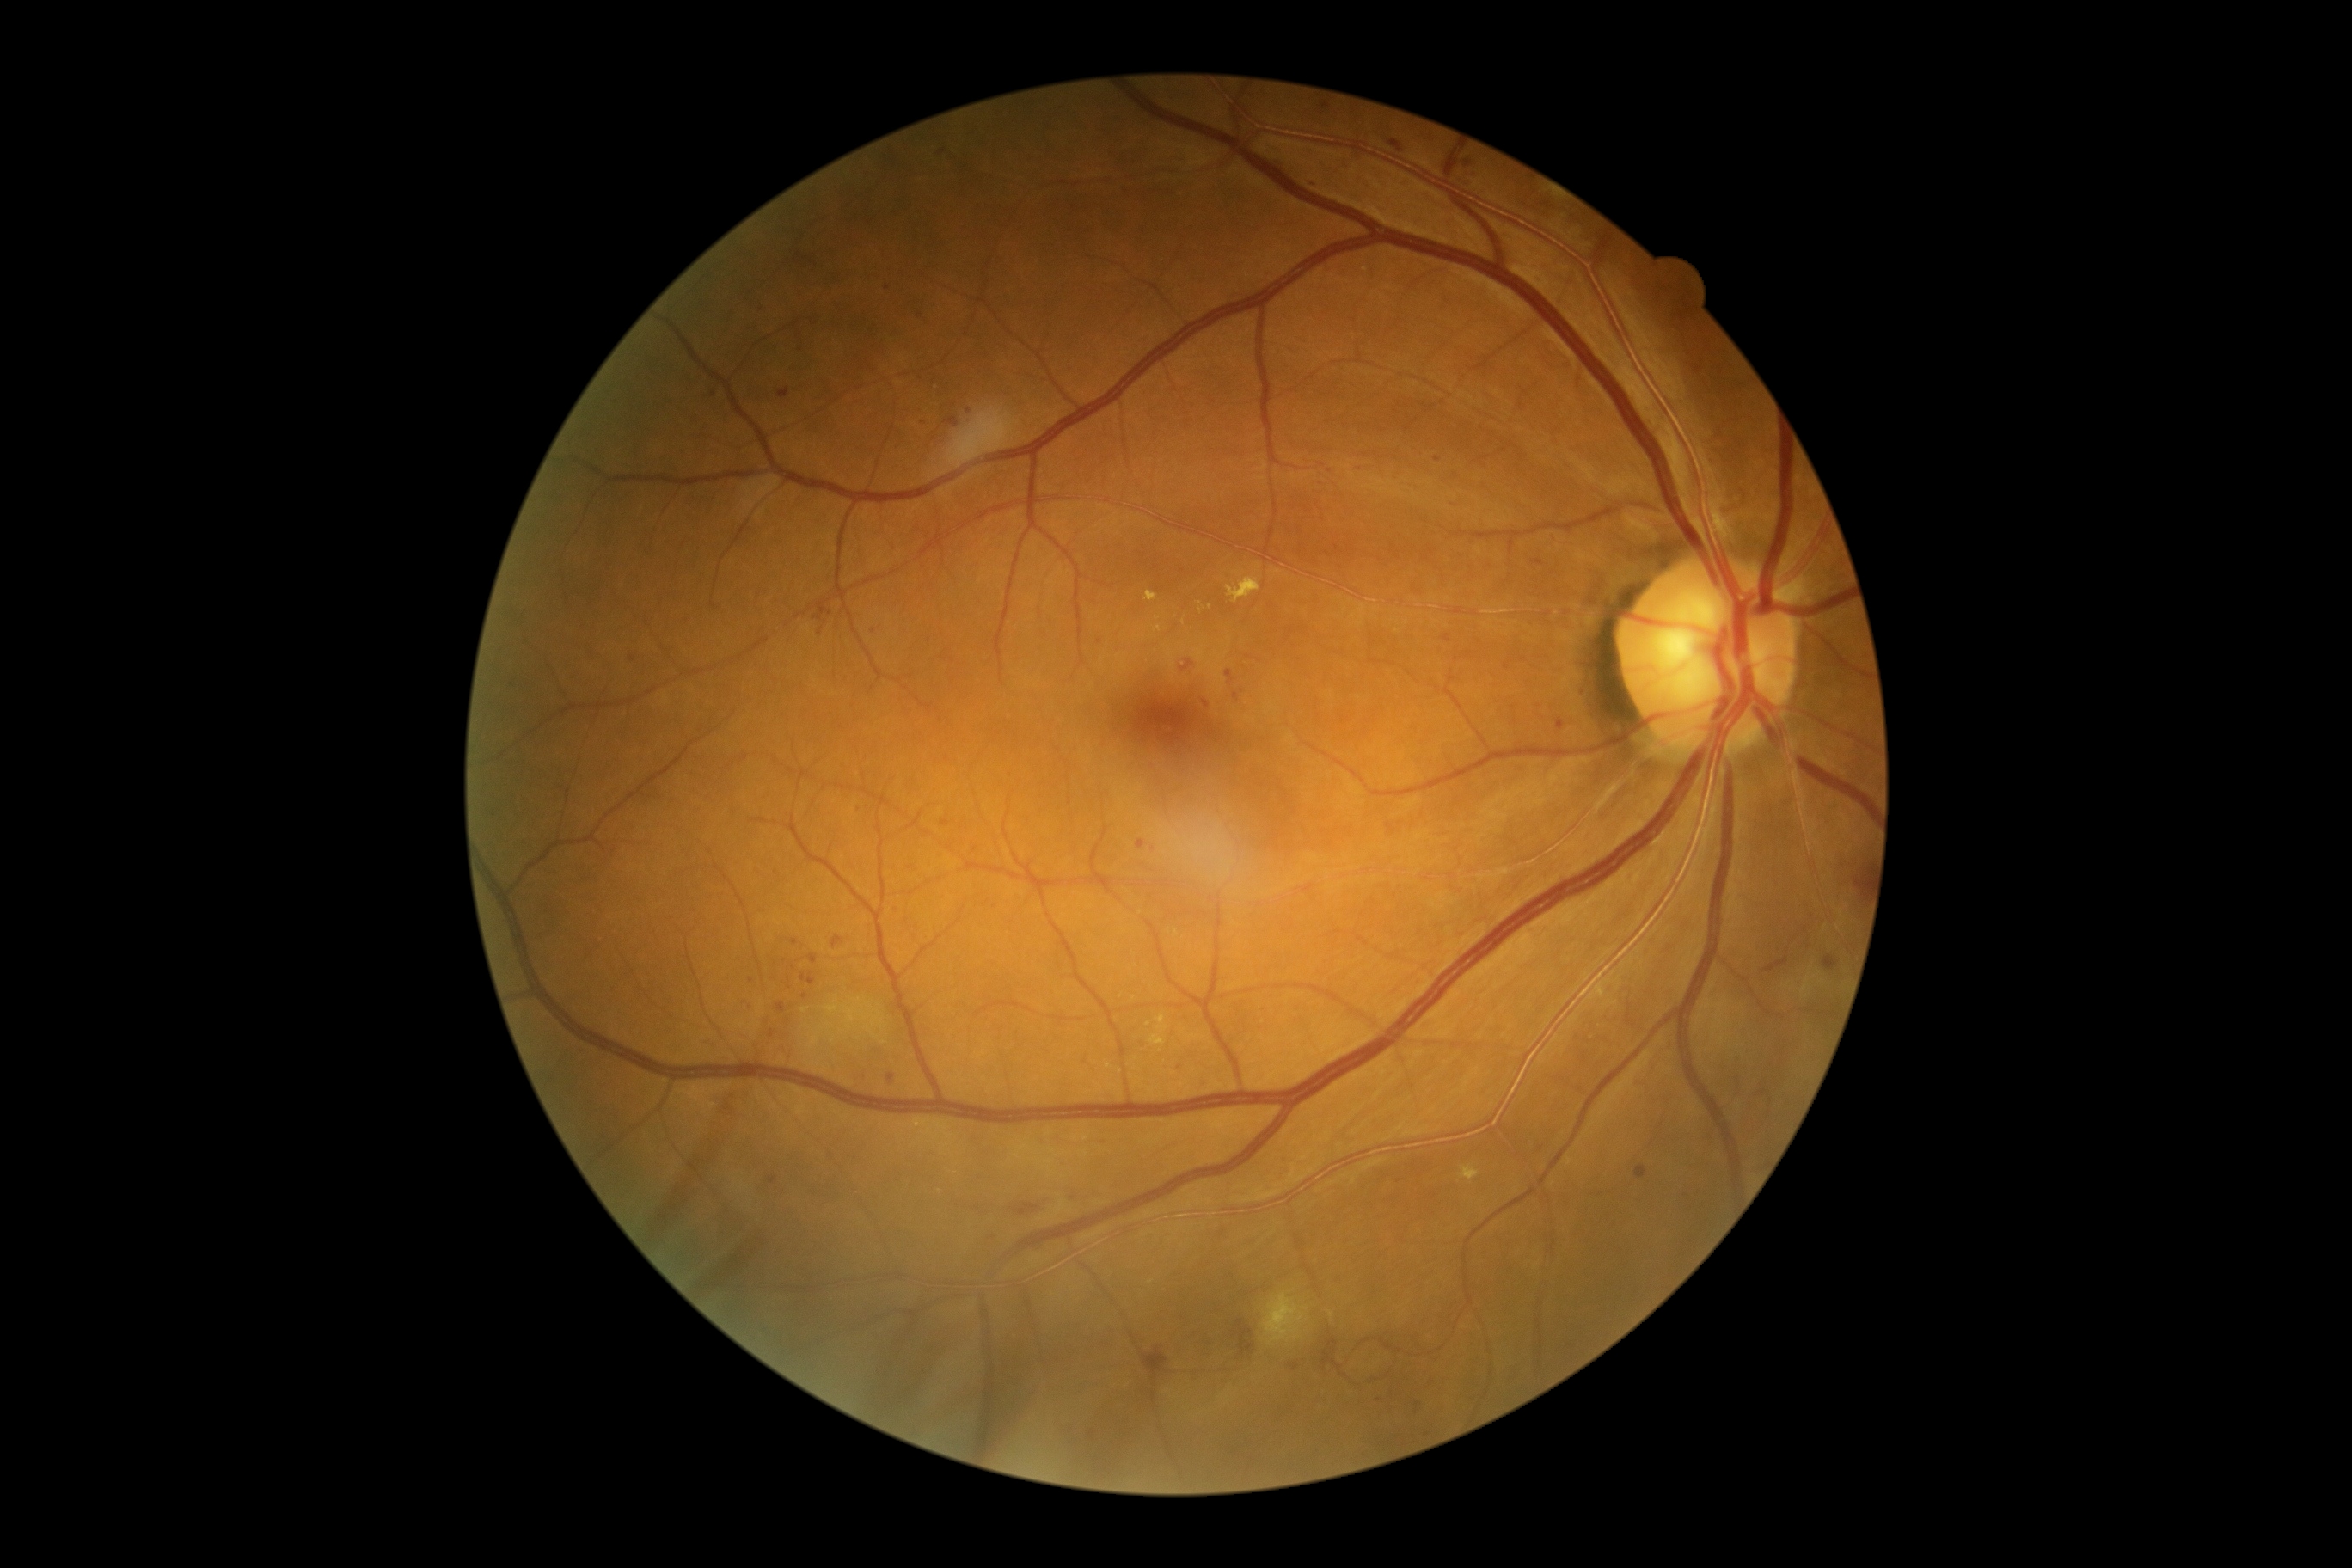 Diabetic retinopathy (DR) is 2/4. Microaneurysms (MAs) are present, including at {"left": 1234, "top": 692, "right": 1239, "bottom": 701} | {"left": 1823, "top": 955, "right": 1841, "bottom": 971} | {"left": 1559, "top": 721, "right": 1565, "bottom": 730} | {"left": 769, "top": 1029, "right": 776, "bottom": 1038} | {"left": 768, "top": 1175, "right": 778, "bottom": 1185} | {"left": 1636, "top": 1167, "right": 1648, "bottom": 1180} | {"left": 1137, "top": 840, "right": 1146, "bottom": 850} | {"left": 1442, "top": 634, "right": 1452, "bottom": 644} | {"left": 778, "top": 388, "right": 790, "bottom": 400} | {"left": 1203, "top": 701, "right": 1210, "bottom": 709} | {"left": 1388, "top": 140, "right": 1404, "bottom": 152} | {"left": 1321, "top": 104, "right": 1332, "bottom": 111}. Additional small MAs near {"x": 1431, "y": 551} | {"x": 888, "y": 288} | {"x": 946, "y": 824} | {"x": 1514, "y": 709} | {"x": 873, "y": 631} | {"x": 891, "y": 1078} | {"x": 751, "y": 981} | {"x": 1438, "y": 460}.